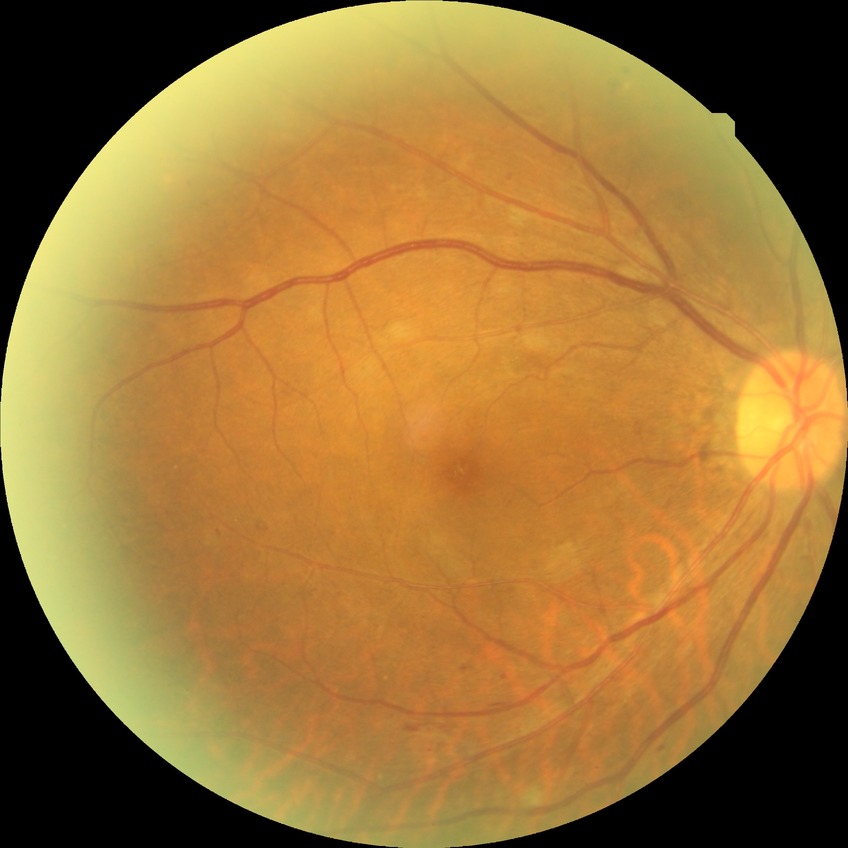

DR is SDR.